Infant wide-field fundus photograph: 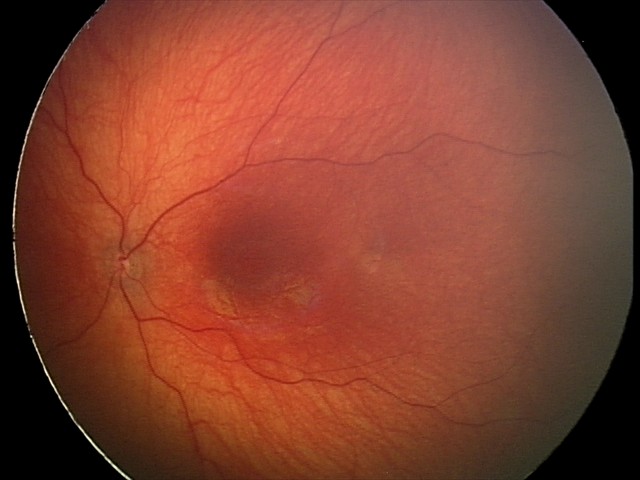

Screening: no abnormal retinal findings.